45° field of view: 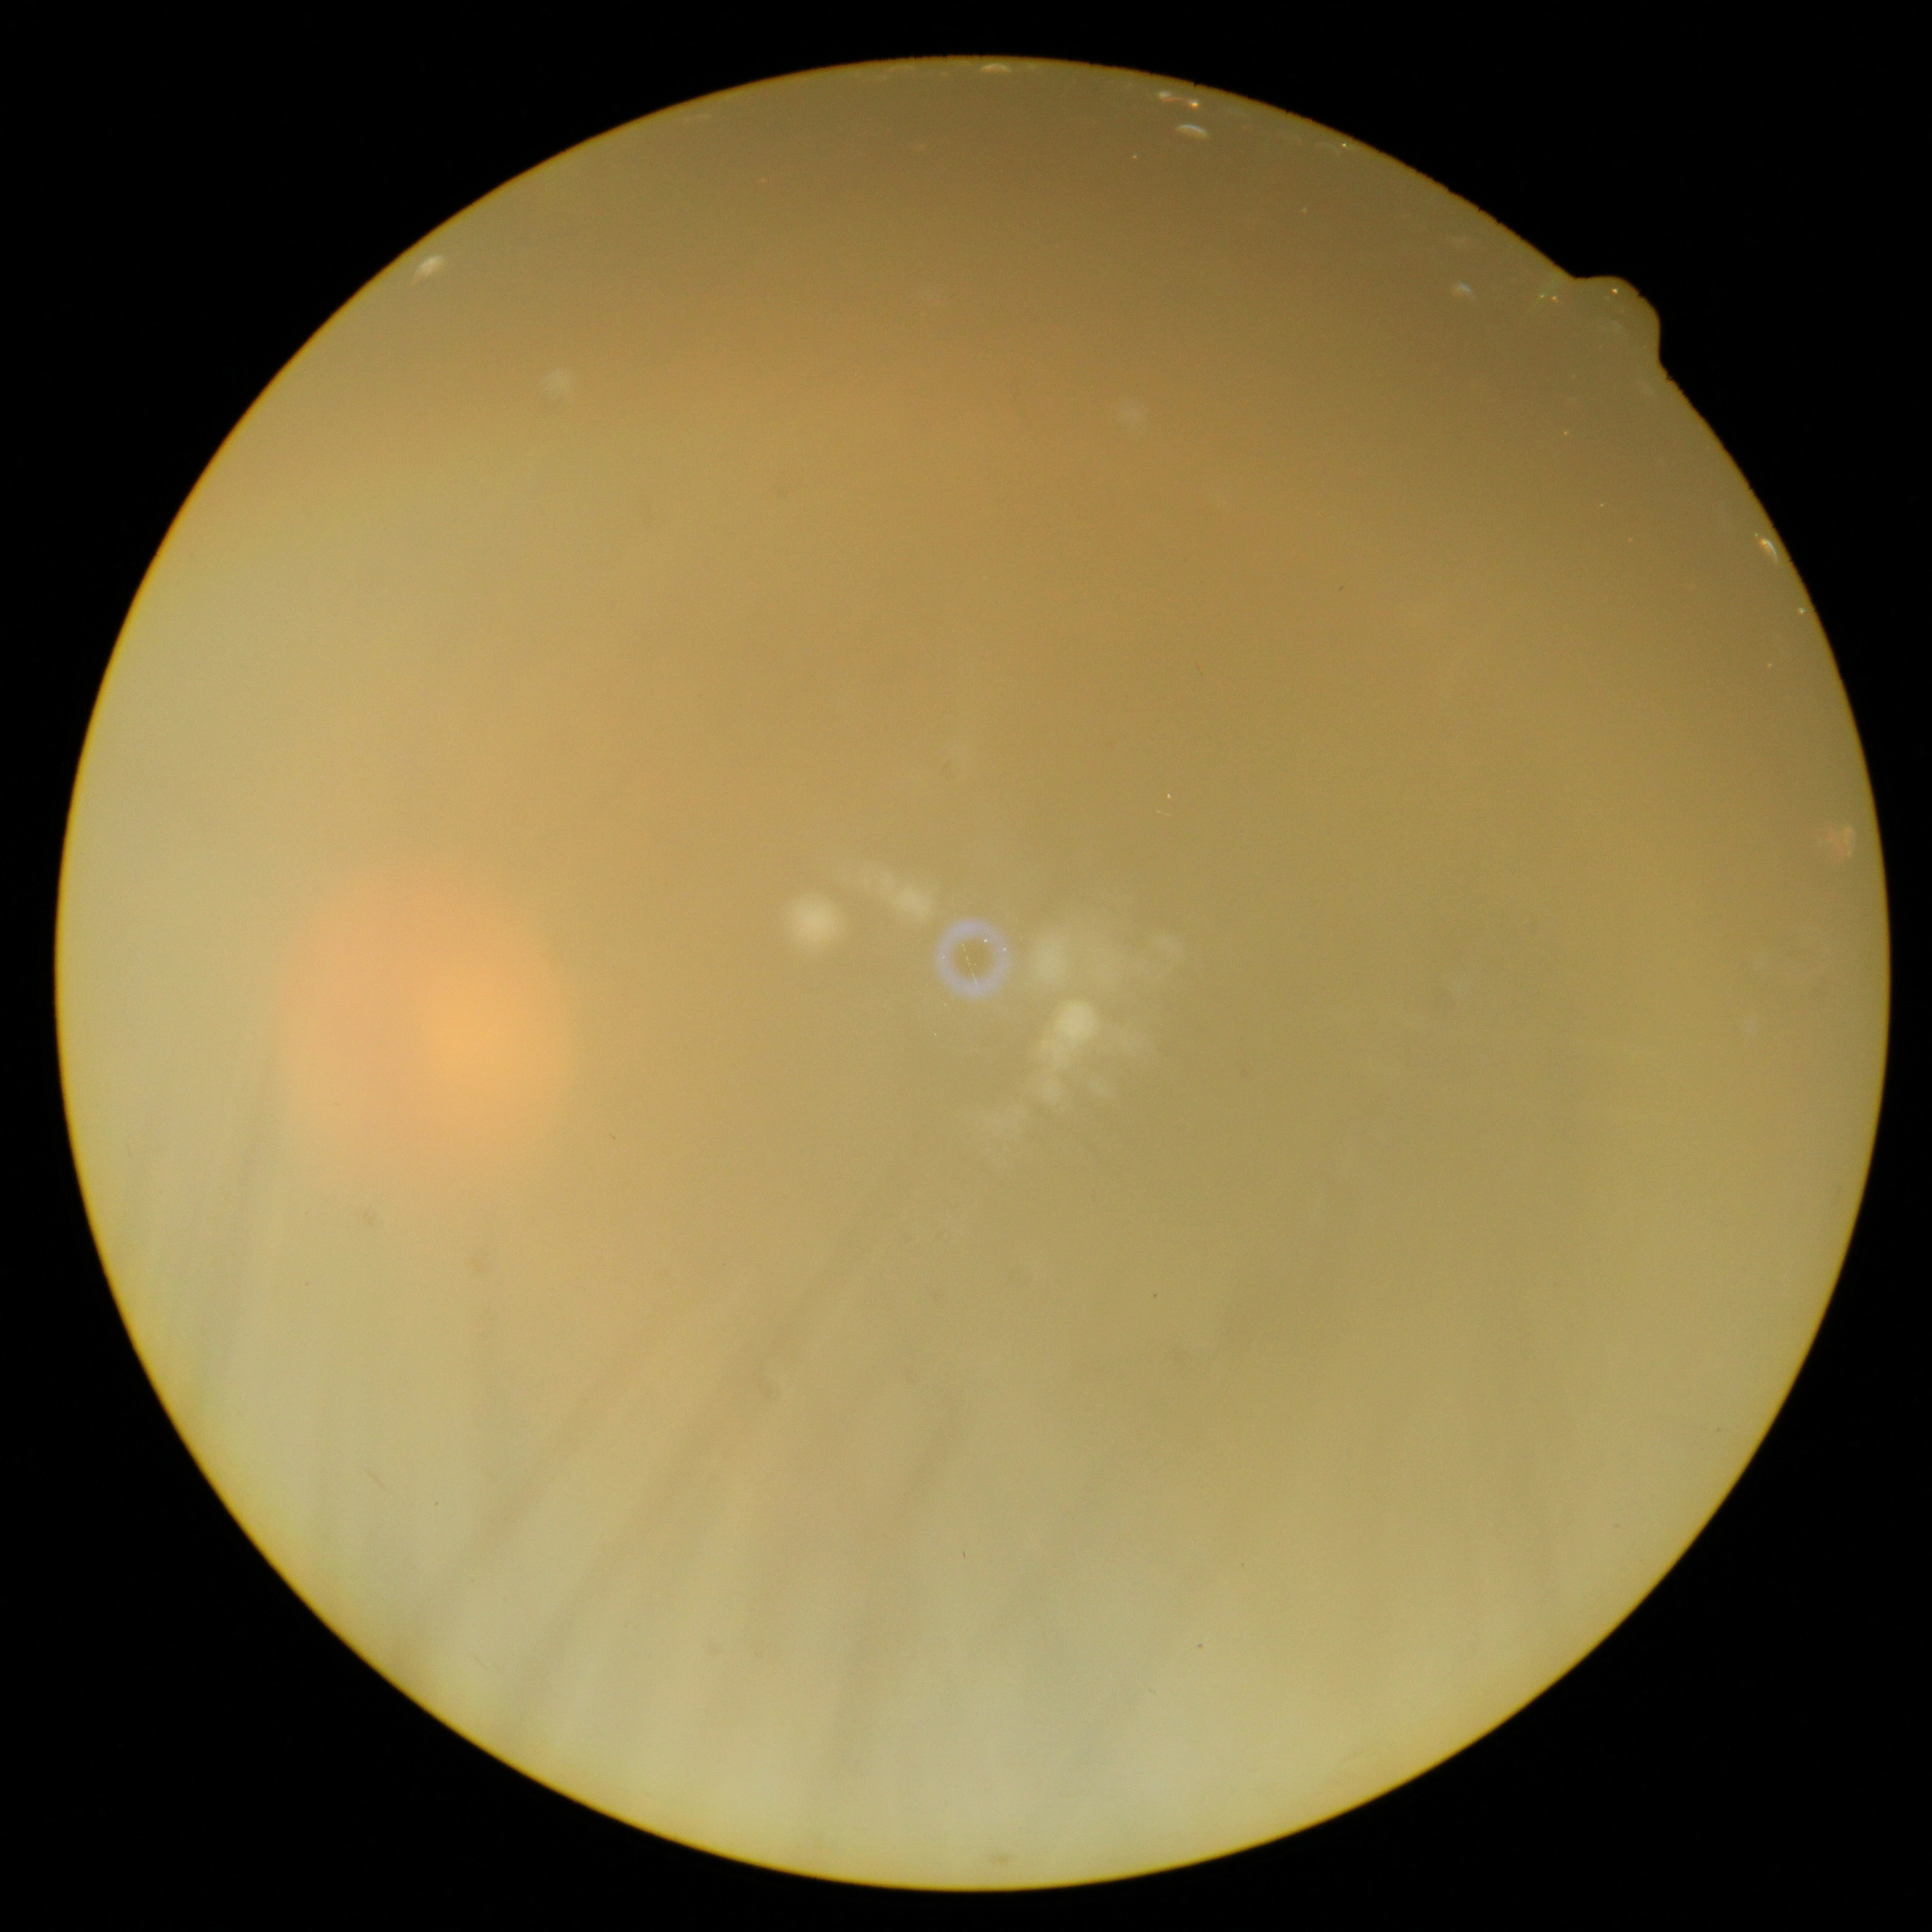 Ungradable image — DR severity cannot be determined. Diabetic retinopathy (DR): ungradable.